Modified Davis grading: 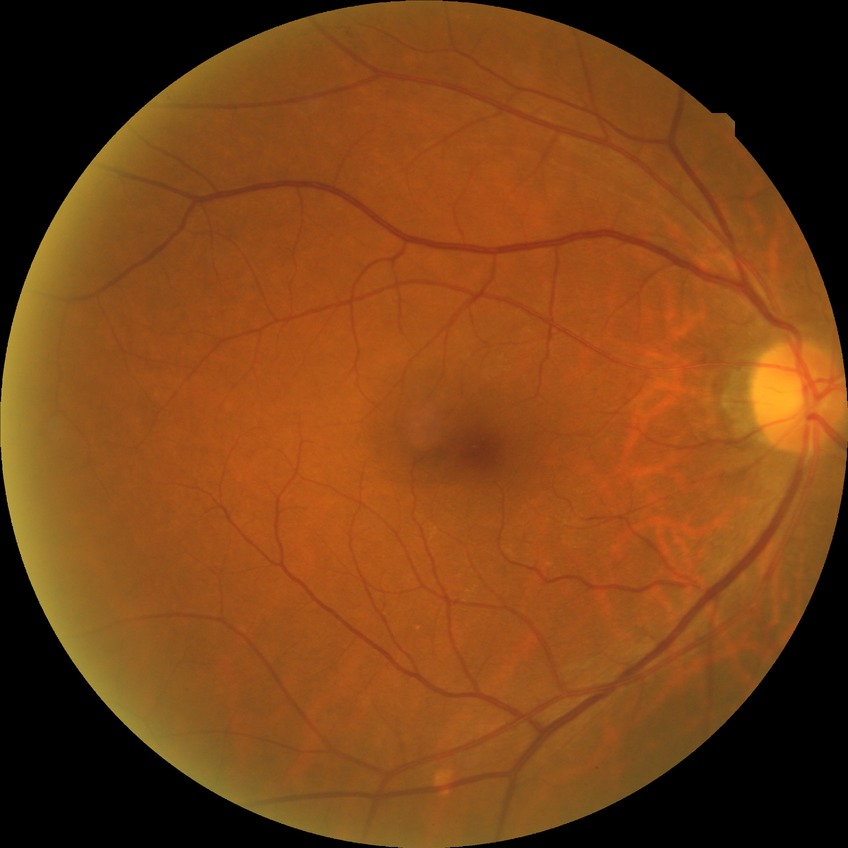

Diabetic retinopathy (DR) is NDR (no diabetic retinopathy).